Pupil-dilated. Image size 2228x1652 — 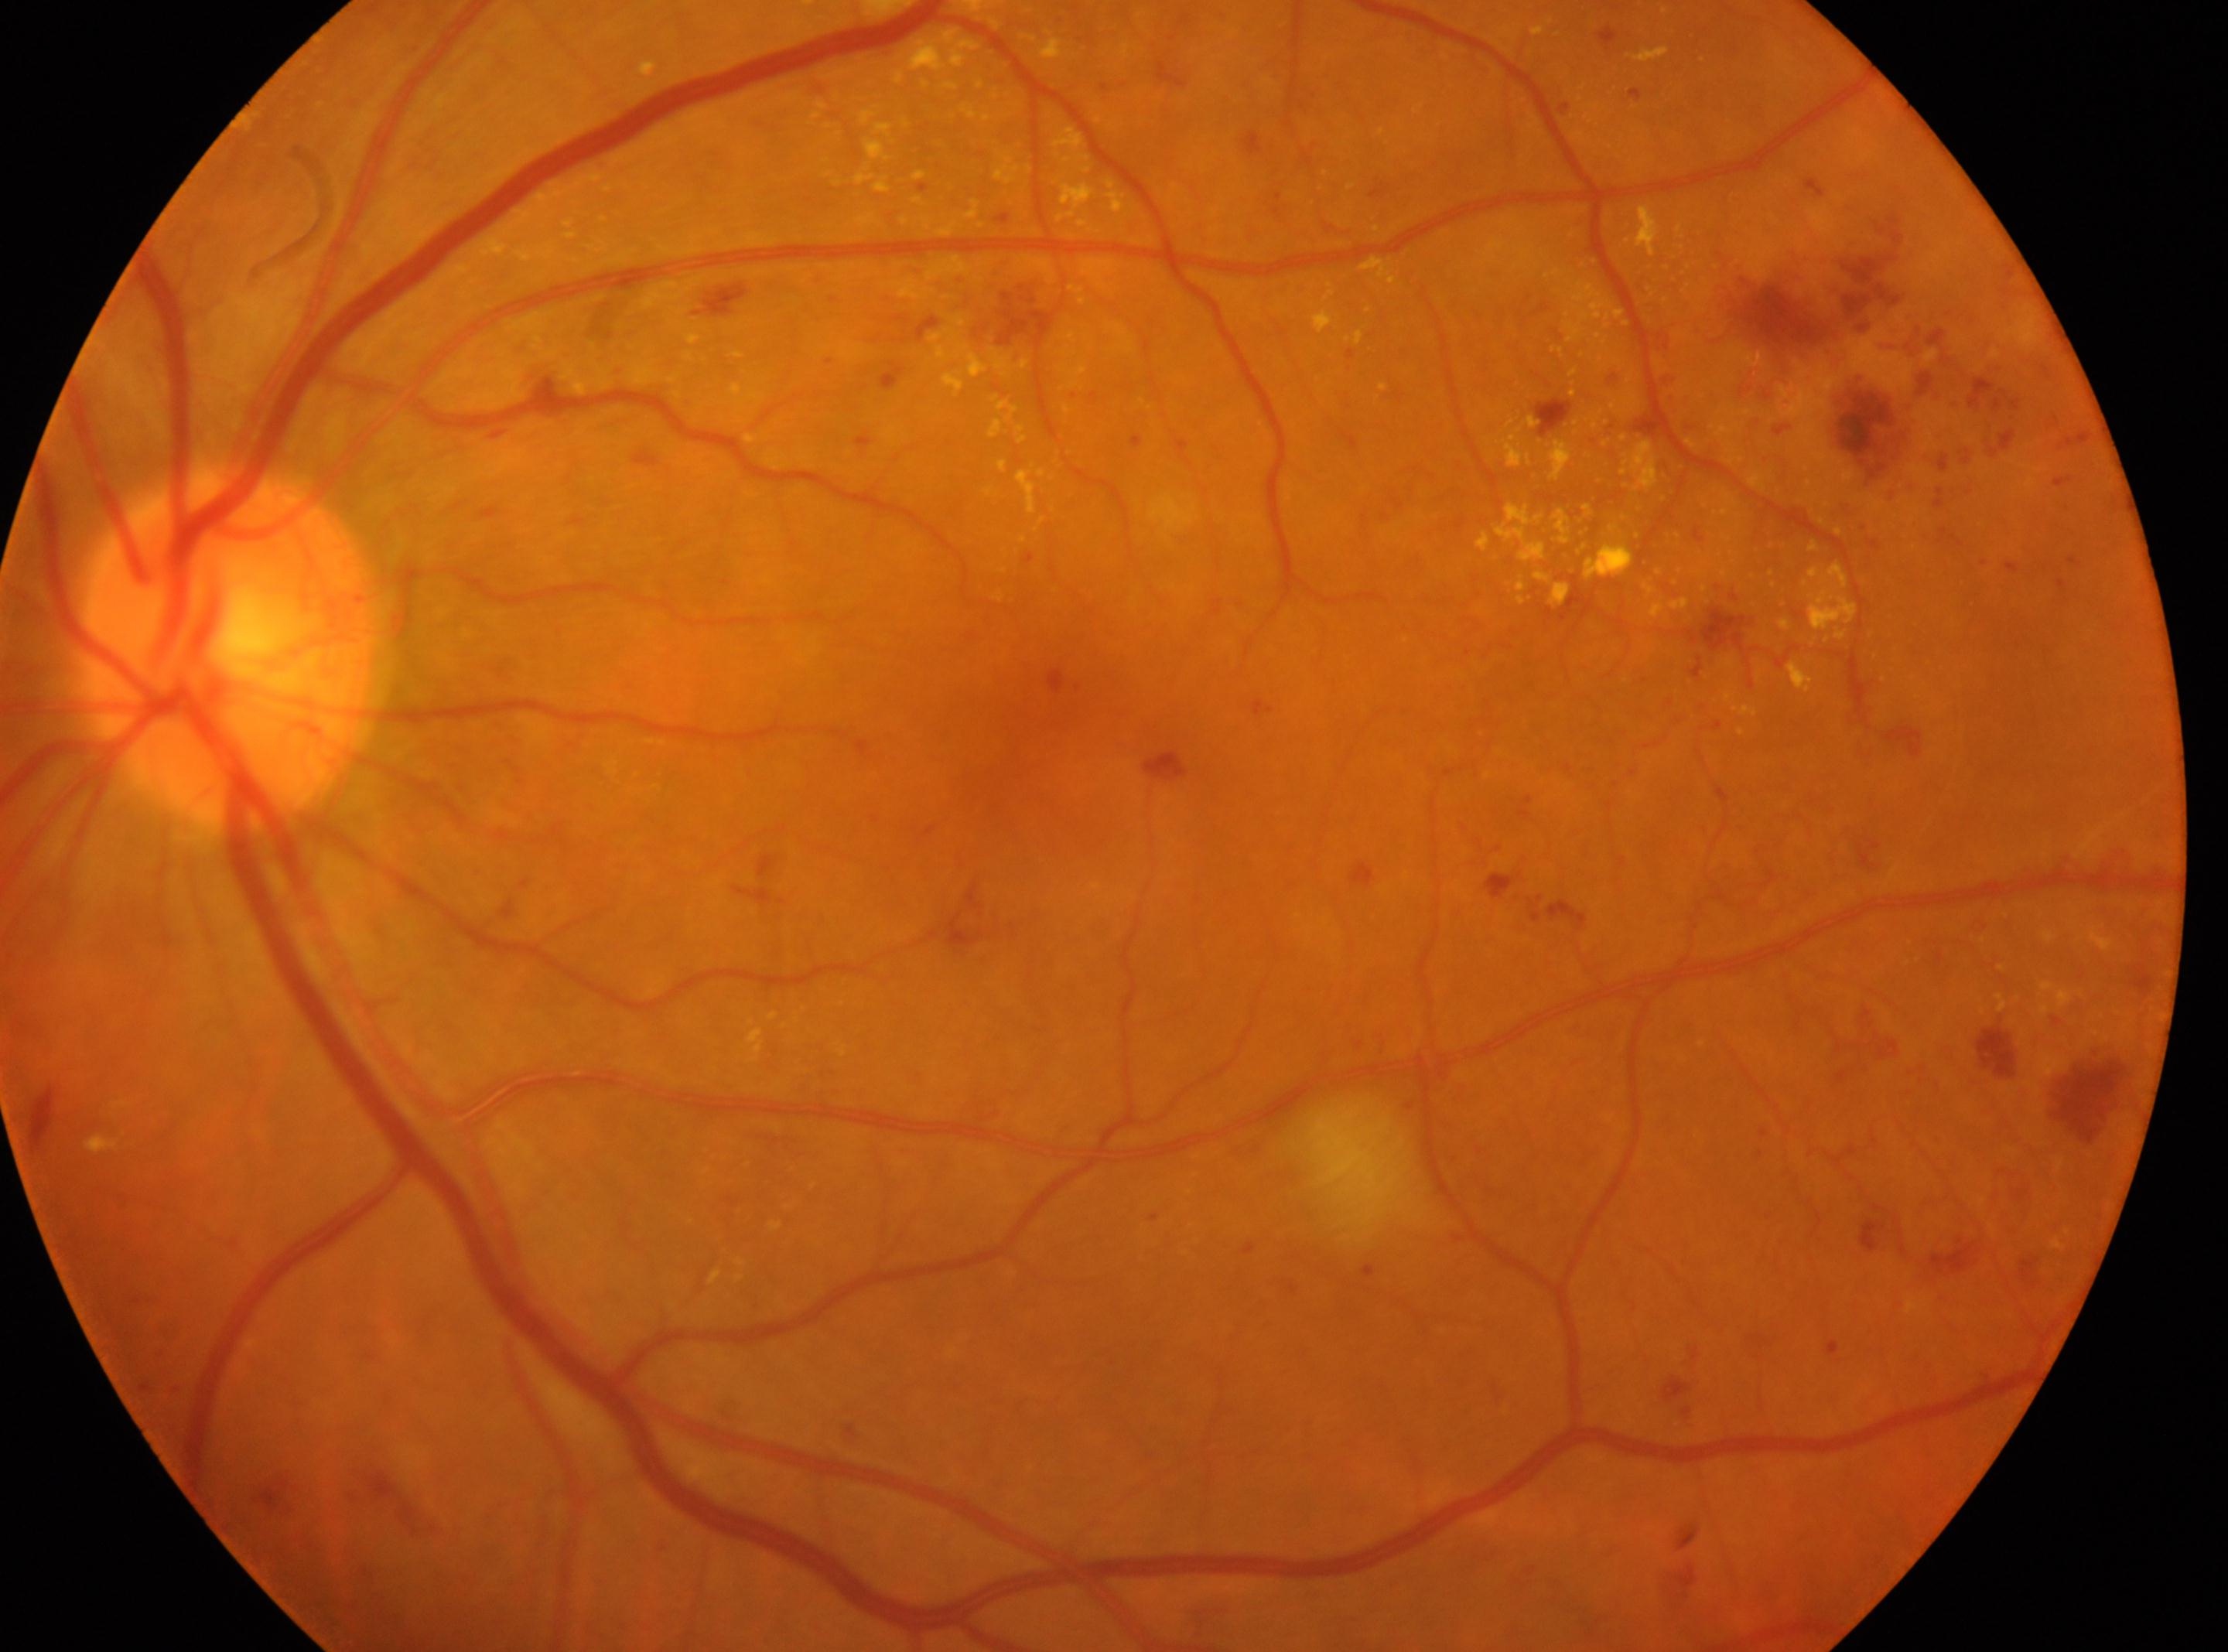
Optic disk: 229px, 650px.
Diabetic retinopathy (DR) is moderate NPDR (grade 2).
Imaged eye: left eye.
The macular center is at 1010px, 756px.
Disease class: non-proliferative diabetic retinopathy.